45-degree field of view: 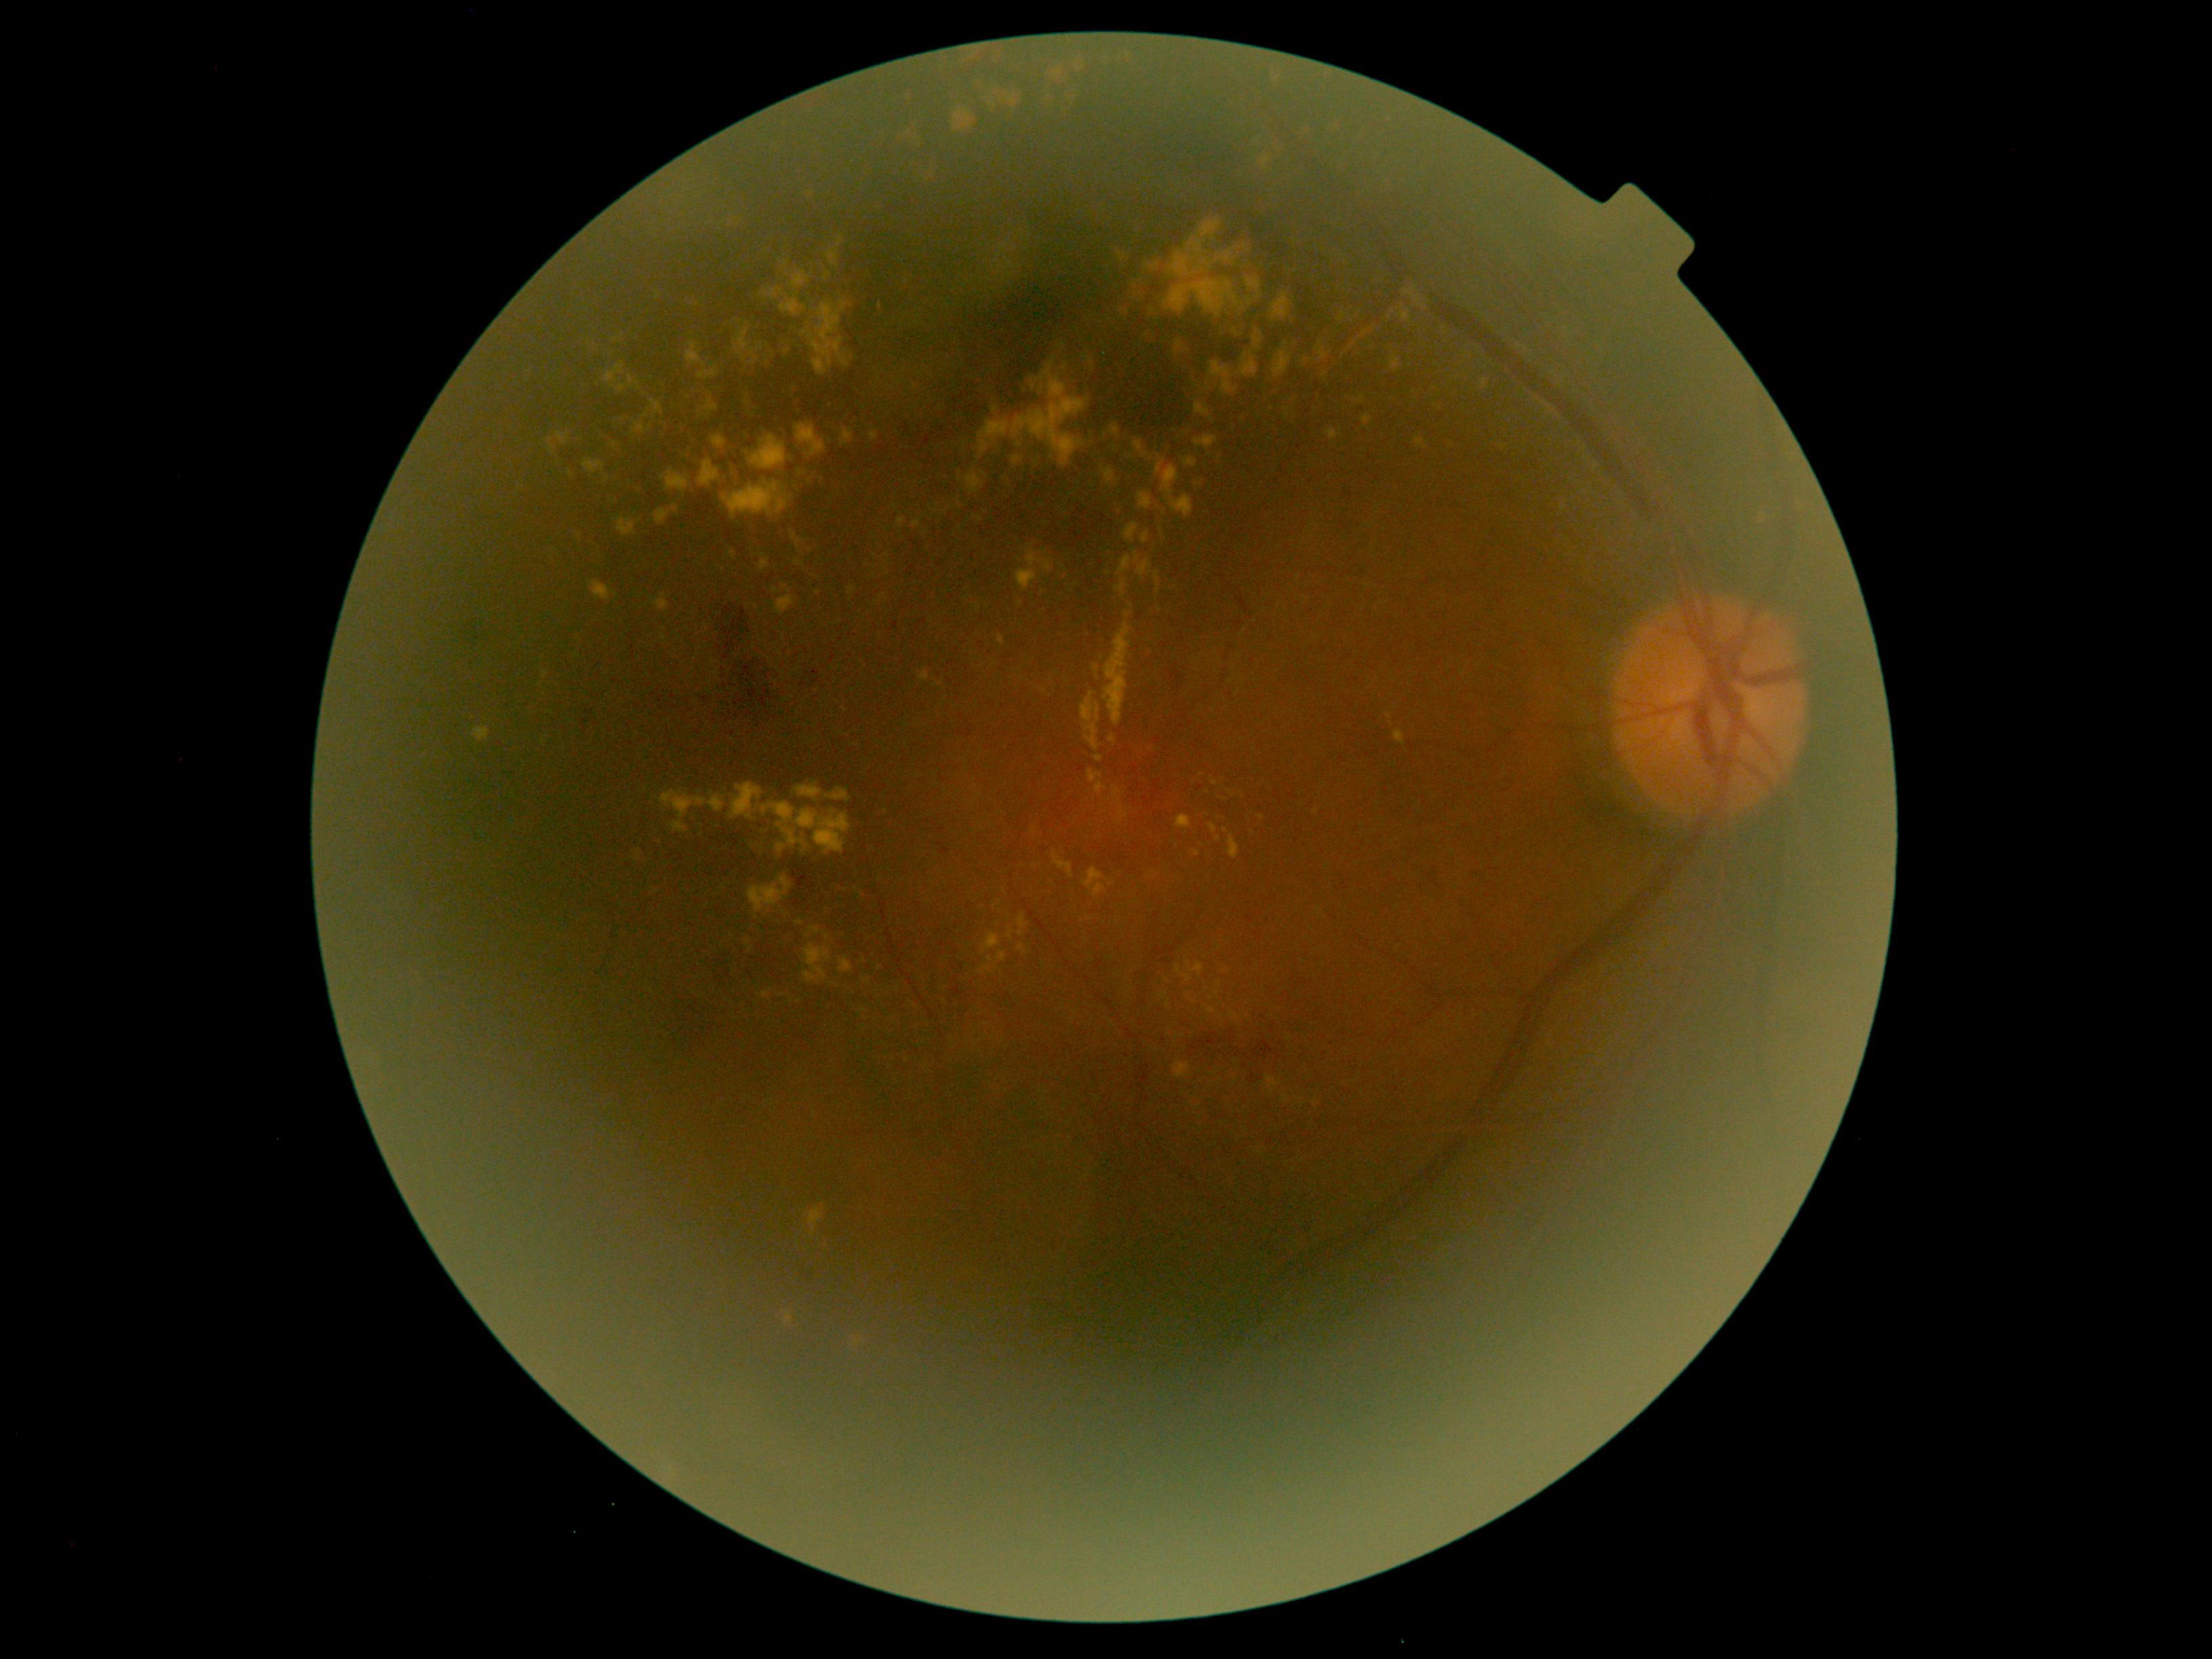 {"partial": true, "dr_grade": 2, "dr_grade_name": "moderate NPDR", "lesions": {"ex": [[746, 939, 753, 954], [1379, 113, 1395, 132], [1211, 777, 1219, 787], [841, 428, 853, 447], [712, 434, 726, 448], [1481, 379, 1488, 388], [979, 966, 993, 975], [1134, 551, 1151, 581], [734, 327, 764, 361], [1257, 815, 1265, 819], [1104, 623, 1131, 726], [966, 474, 985, 494]], "ex_small_approx": [[1220, 984], [855, 744], [615, 446], [1364, 333], [785, 701], [1044, 592], [675, 509]]}}